1240 by 1240 pixels; wide-field fundus image from infant ROP screening:
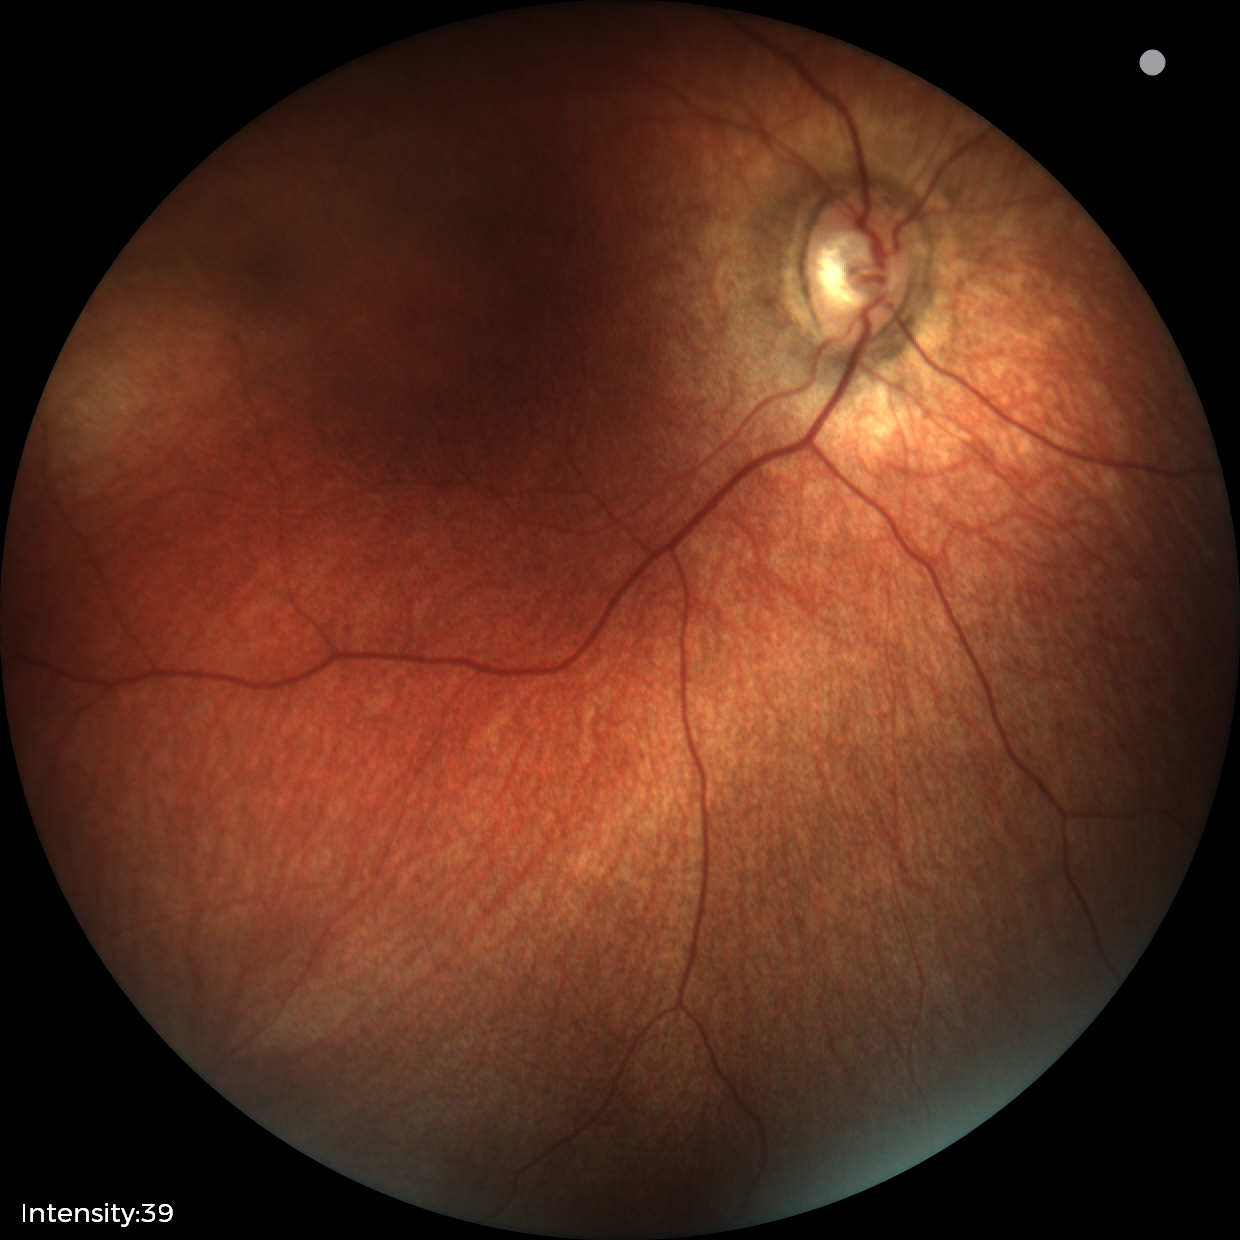

Physiological retinal appearance for postconceptual age.